Modified Davis grading — 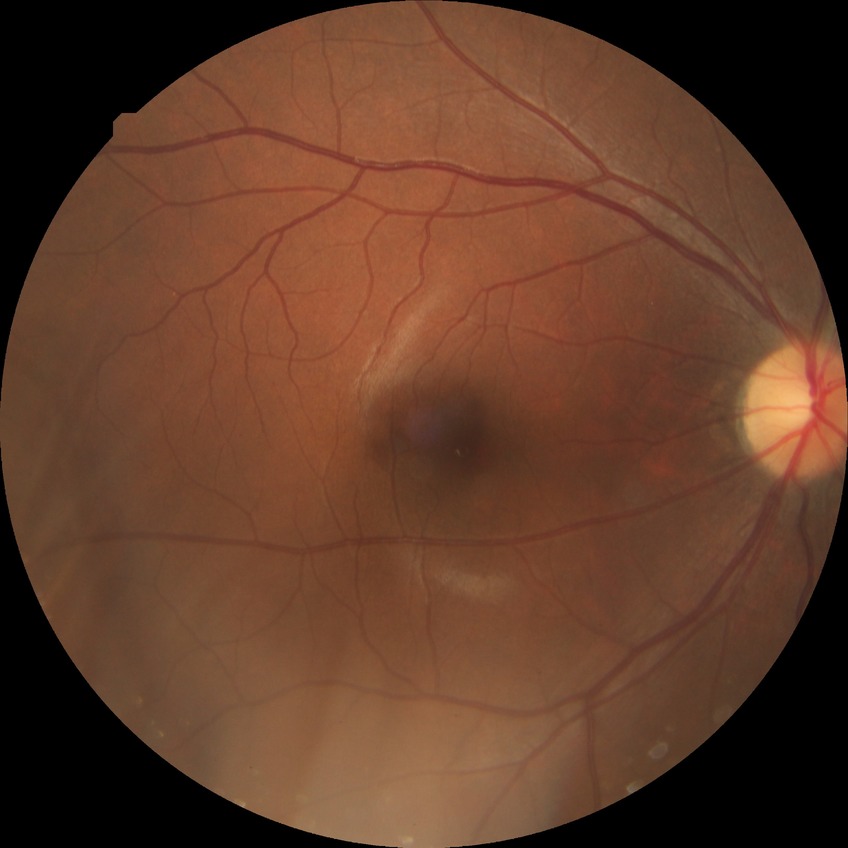 Findings:
- diabetic retinopathy (DR): NDR (no diabetic retinopathy)